Acquired with a NIDEK AFC-230; diabetic retinopathy graded by the modified Davis classification; 848x848 — 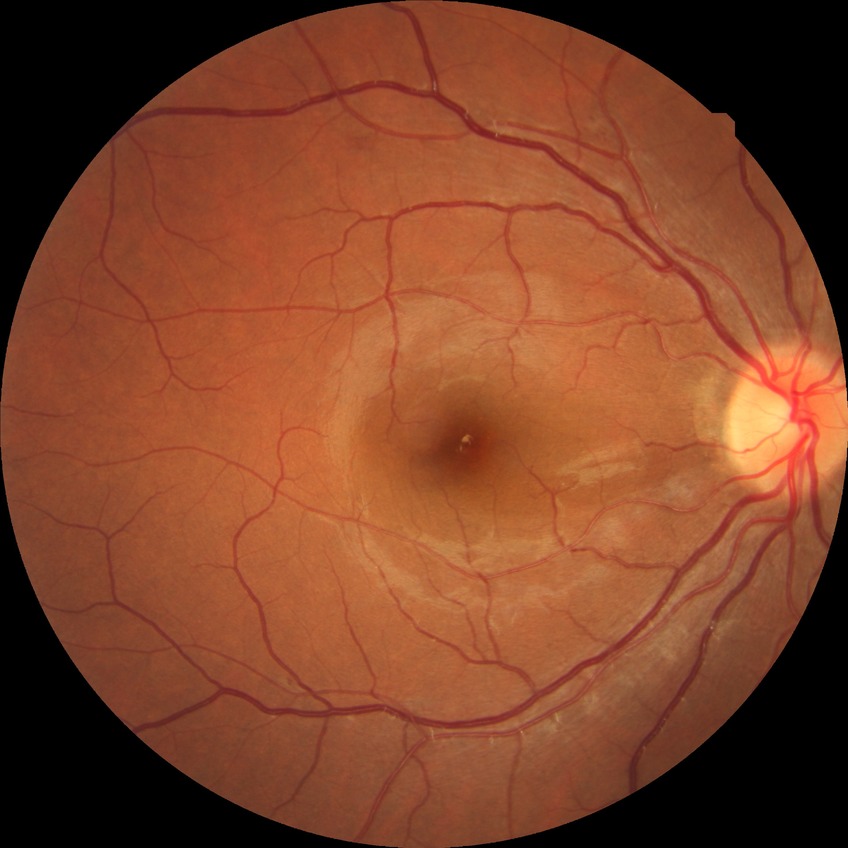
Diabetic retinopathy (DR) is simple diabetic retinopathy (SDR).